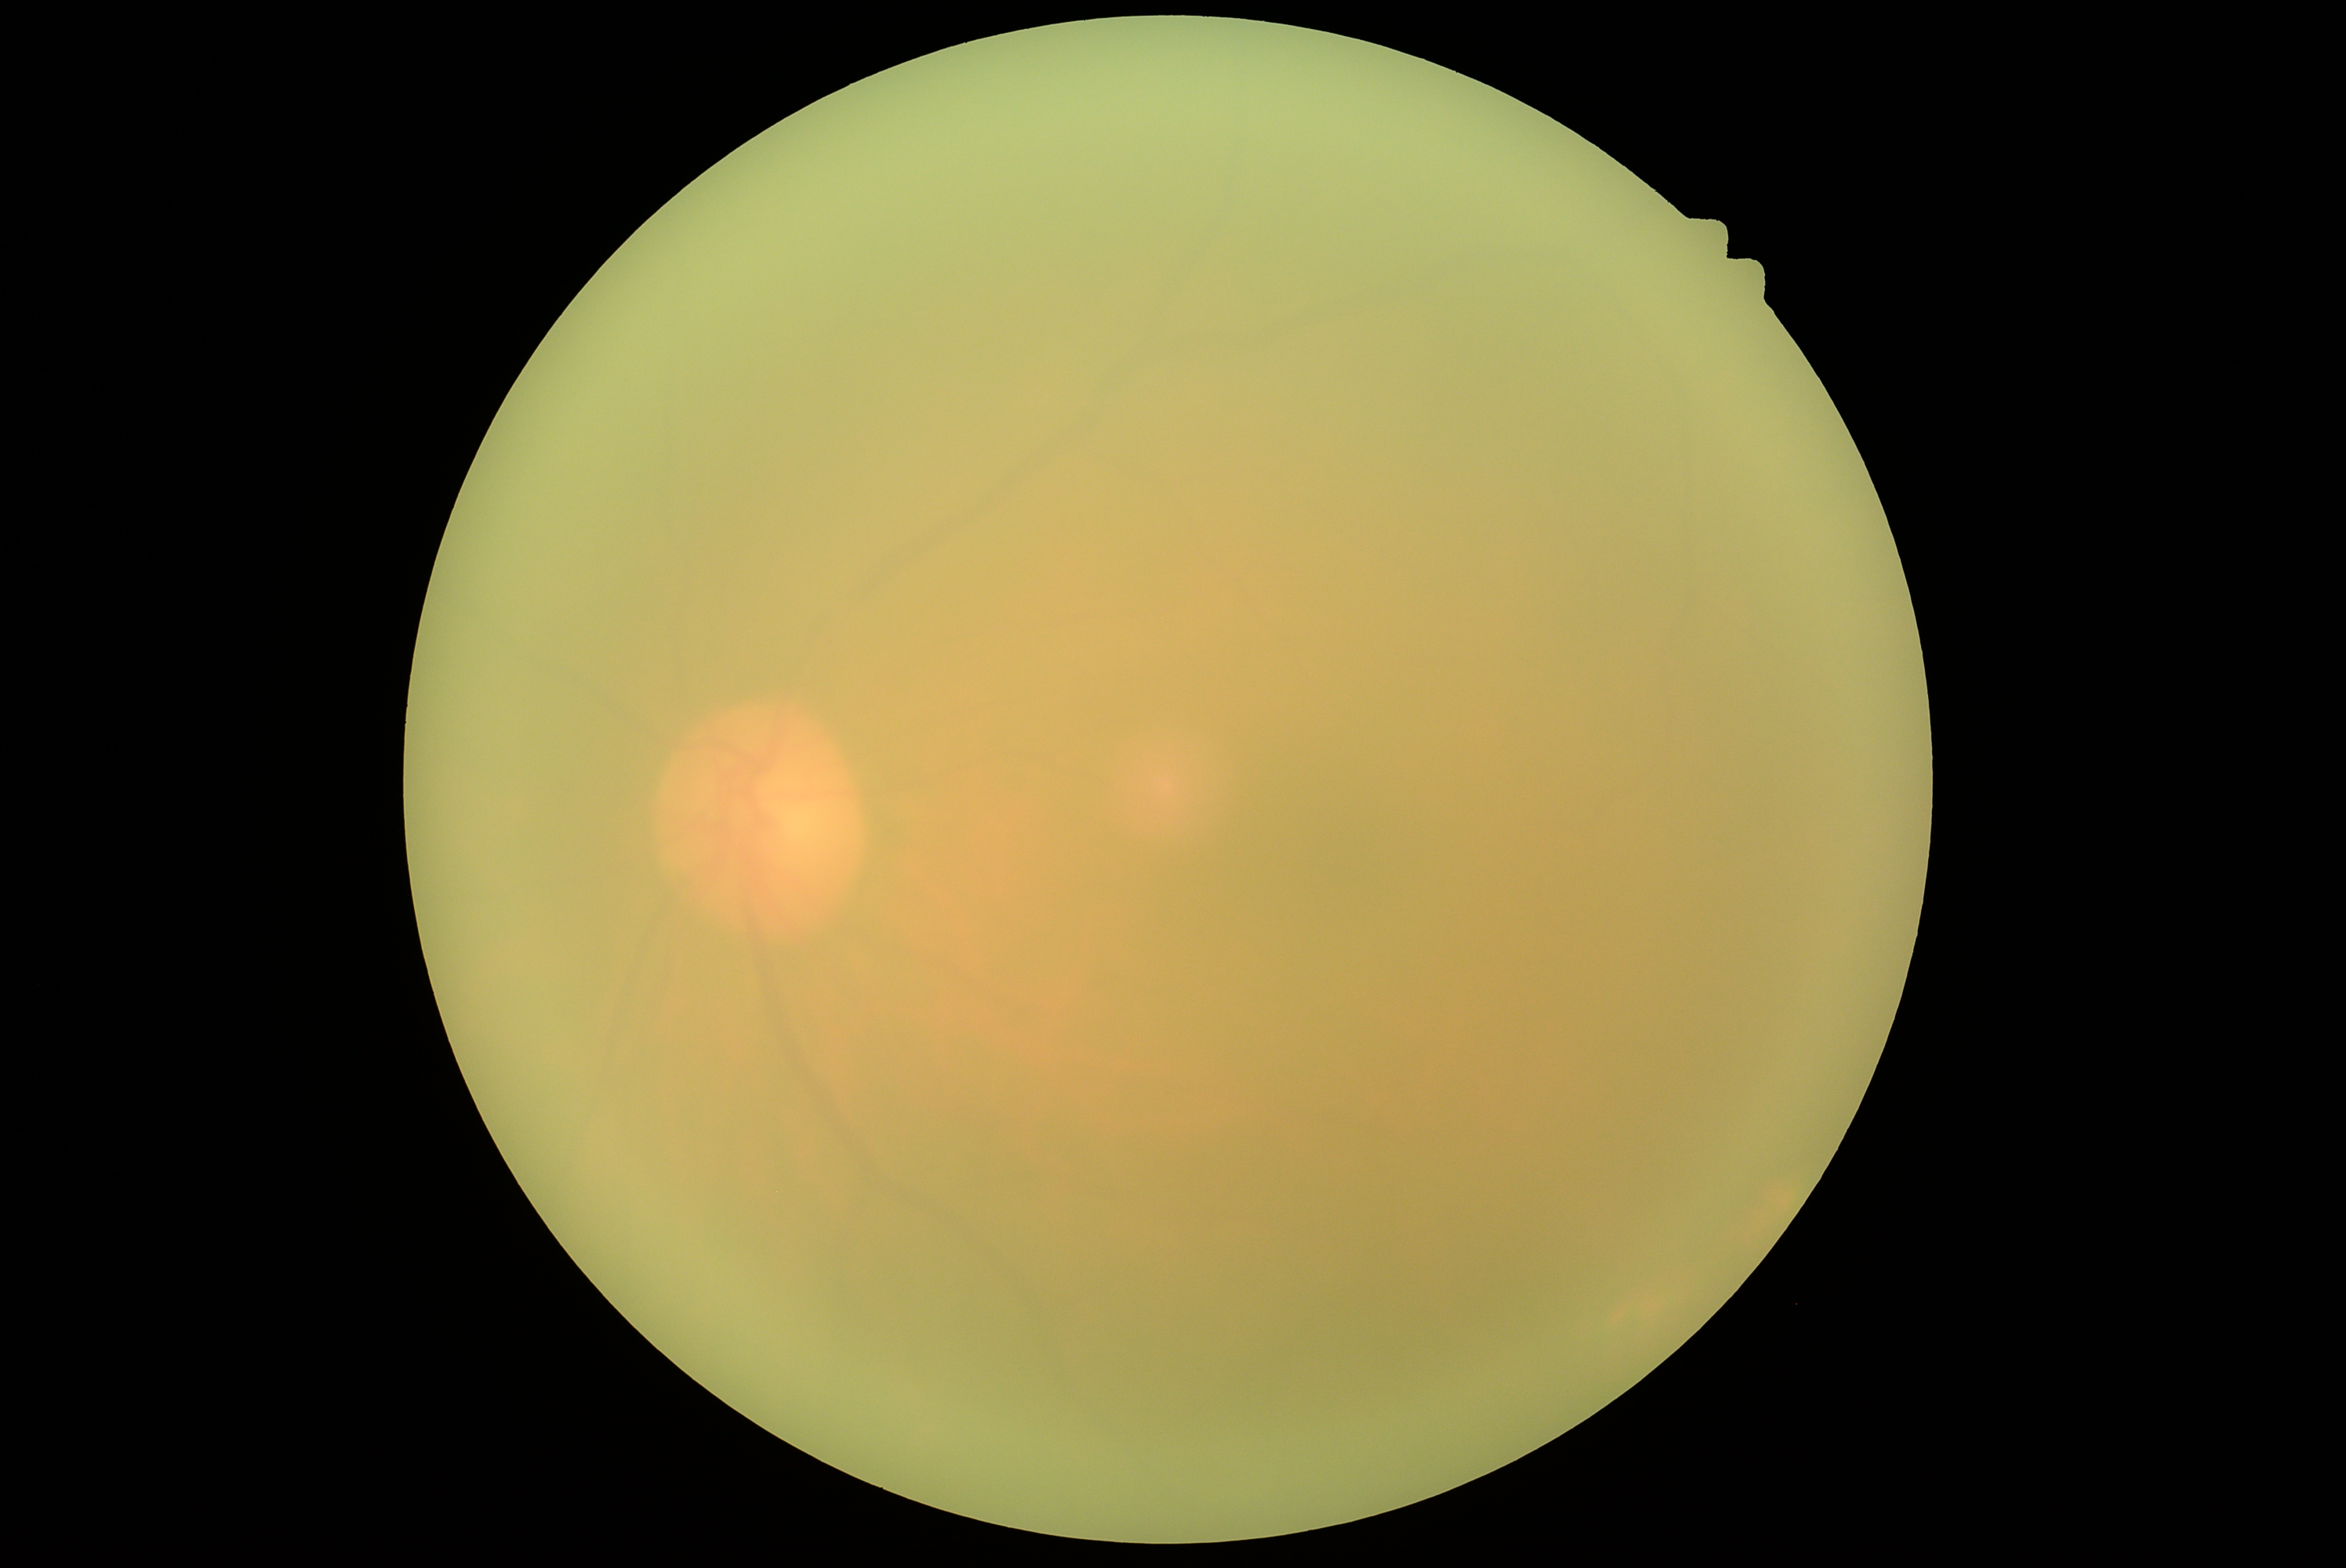 Ungradable image — DR severity cannot be determined. DR grade: ungradable.